CFP
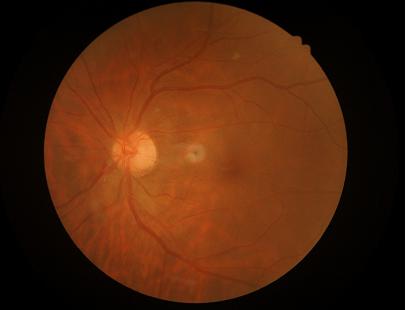

Image quality assessment: contrast: adequate | illumination/color: adequate | overall: adequate.